Color fundus photograph — 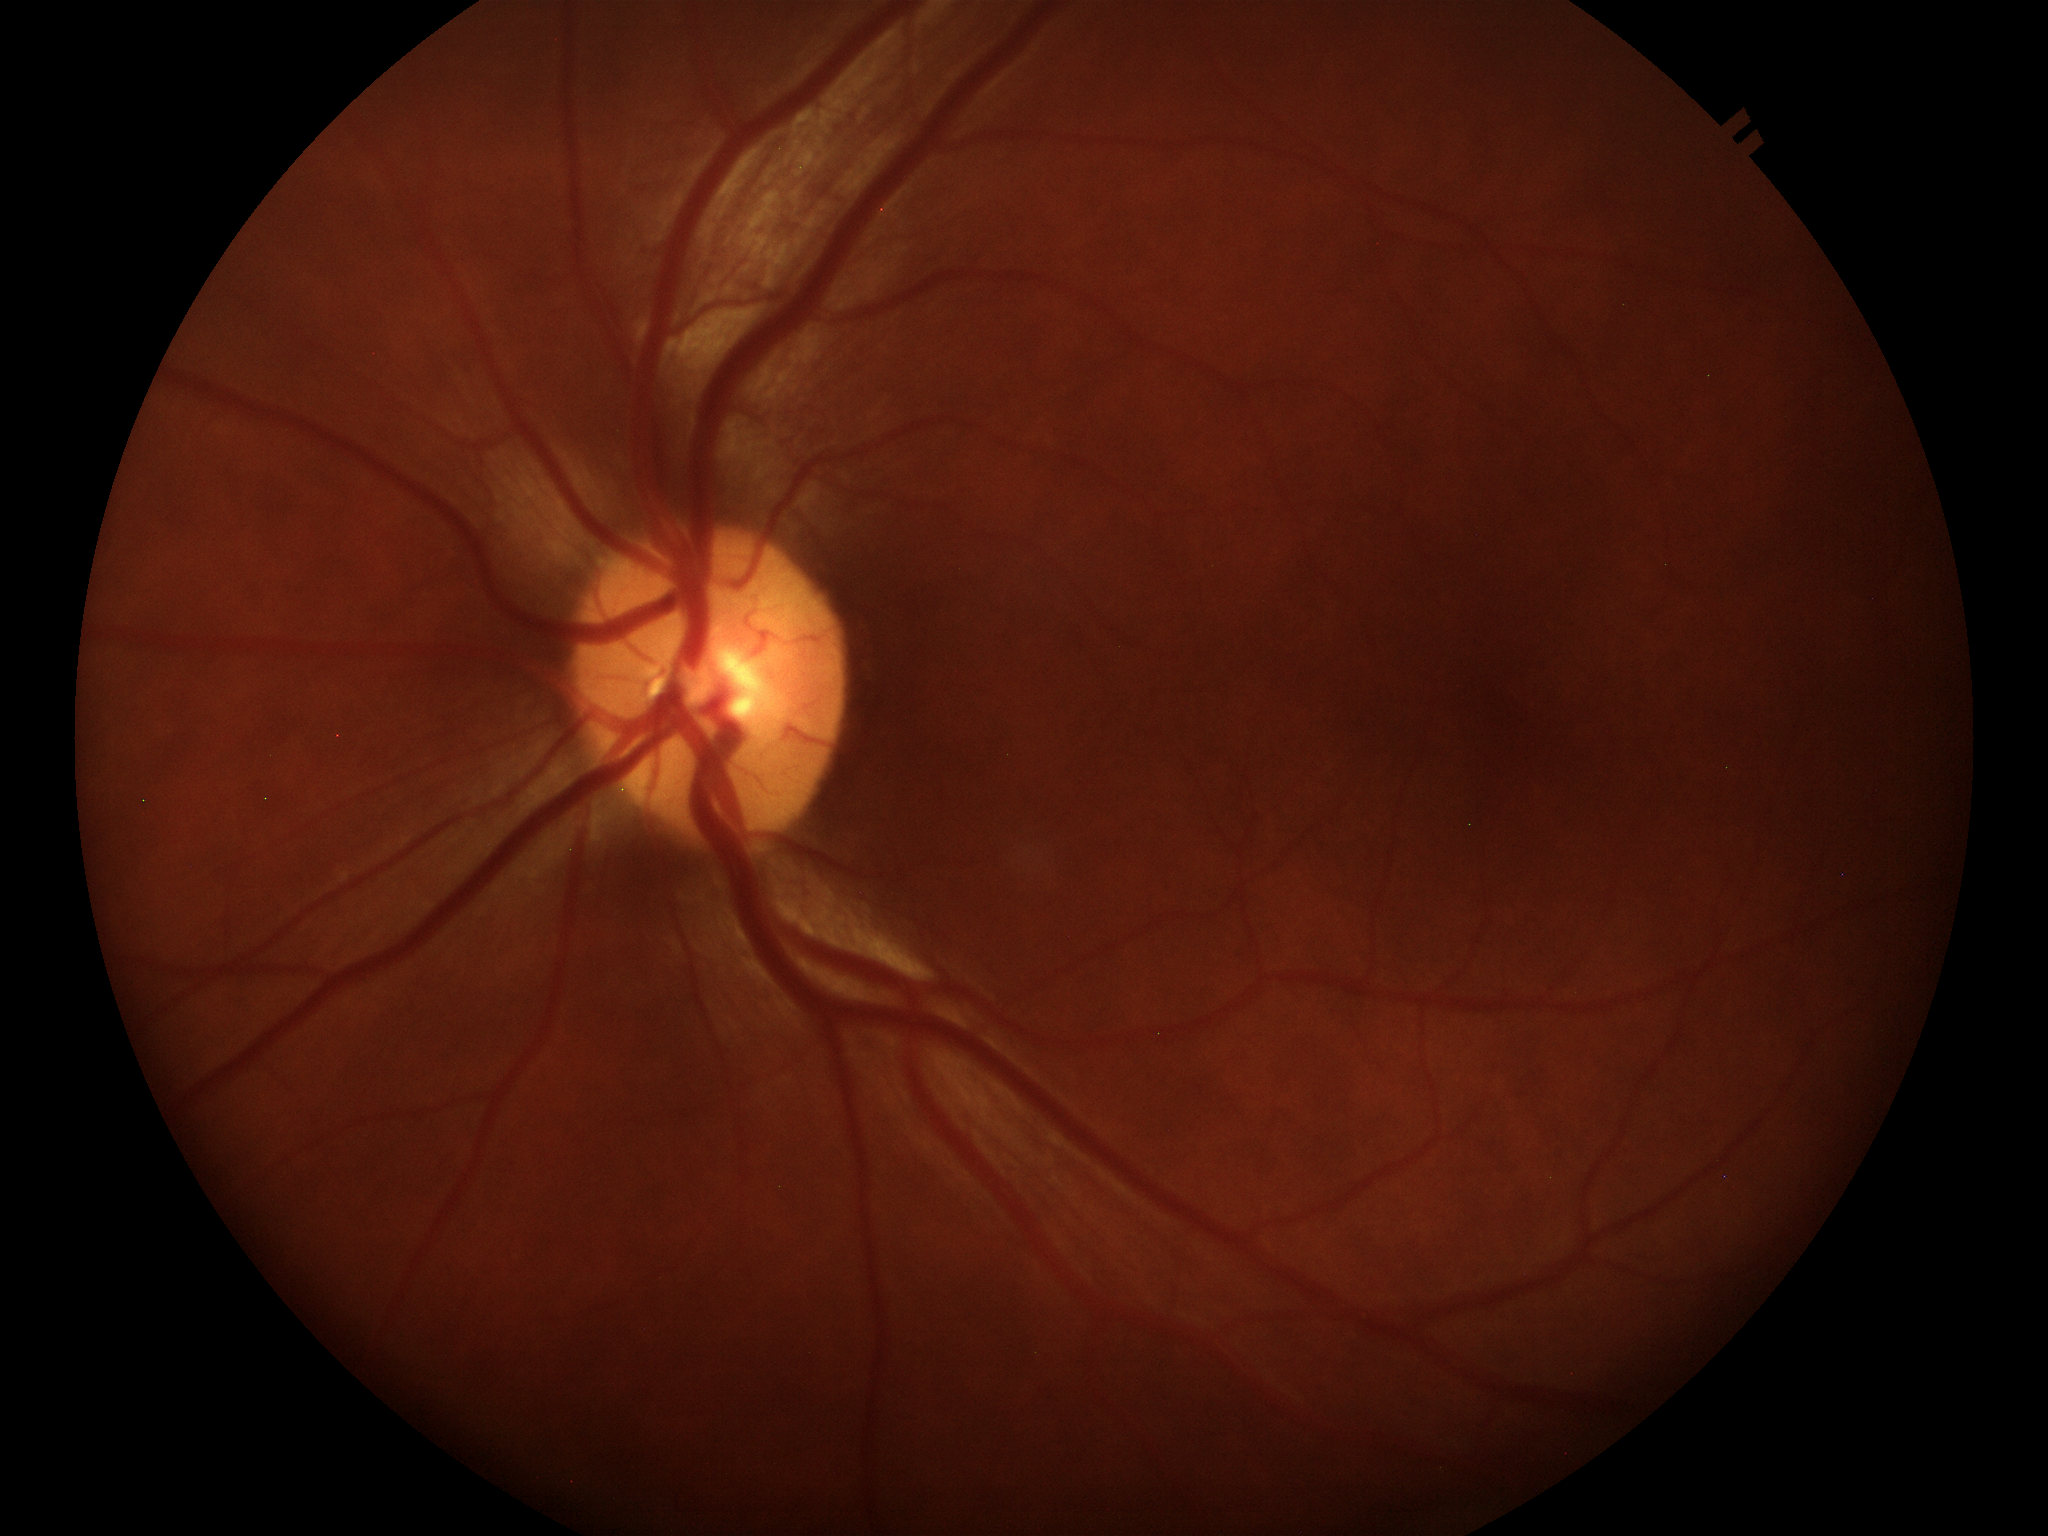

Annotations:
* area cup-to-disc ratio (ACDR): 0.17
* Glaucoma evaluation: not suspect
* vertical CDR (VCDR): 0.37